1440 by 1080 pixels. Infant wide-field fundus photograph
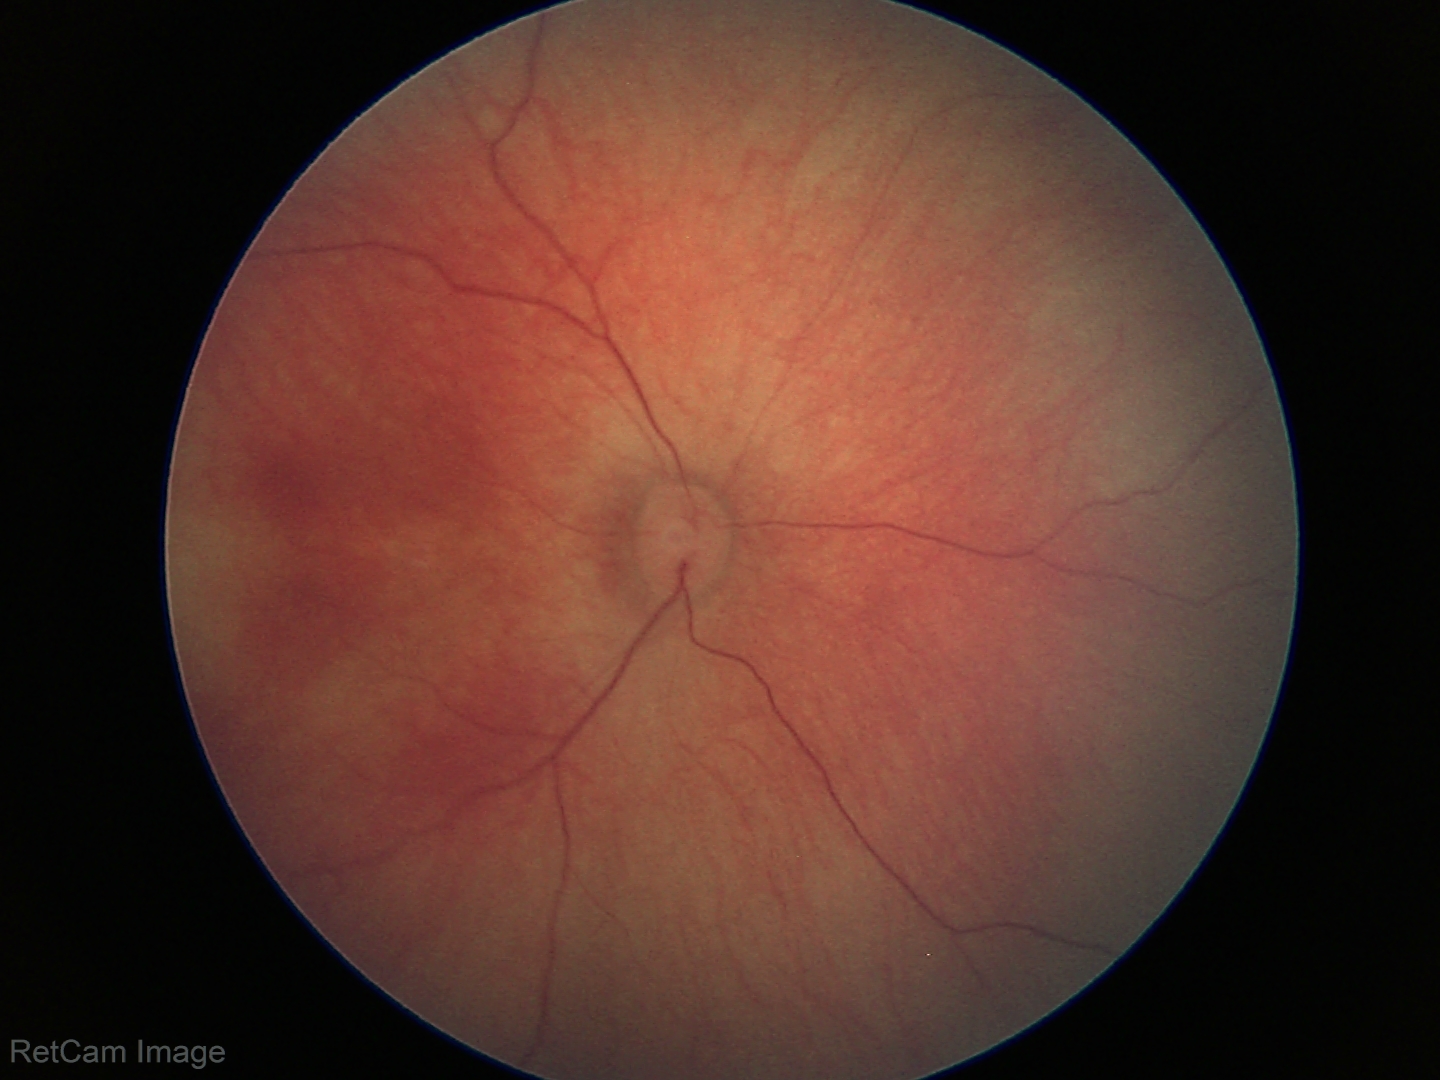 Examination with physiological retinal findings.